FOV: 50 degrees. Kowa VX-10α. Color fundus photograph
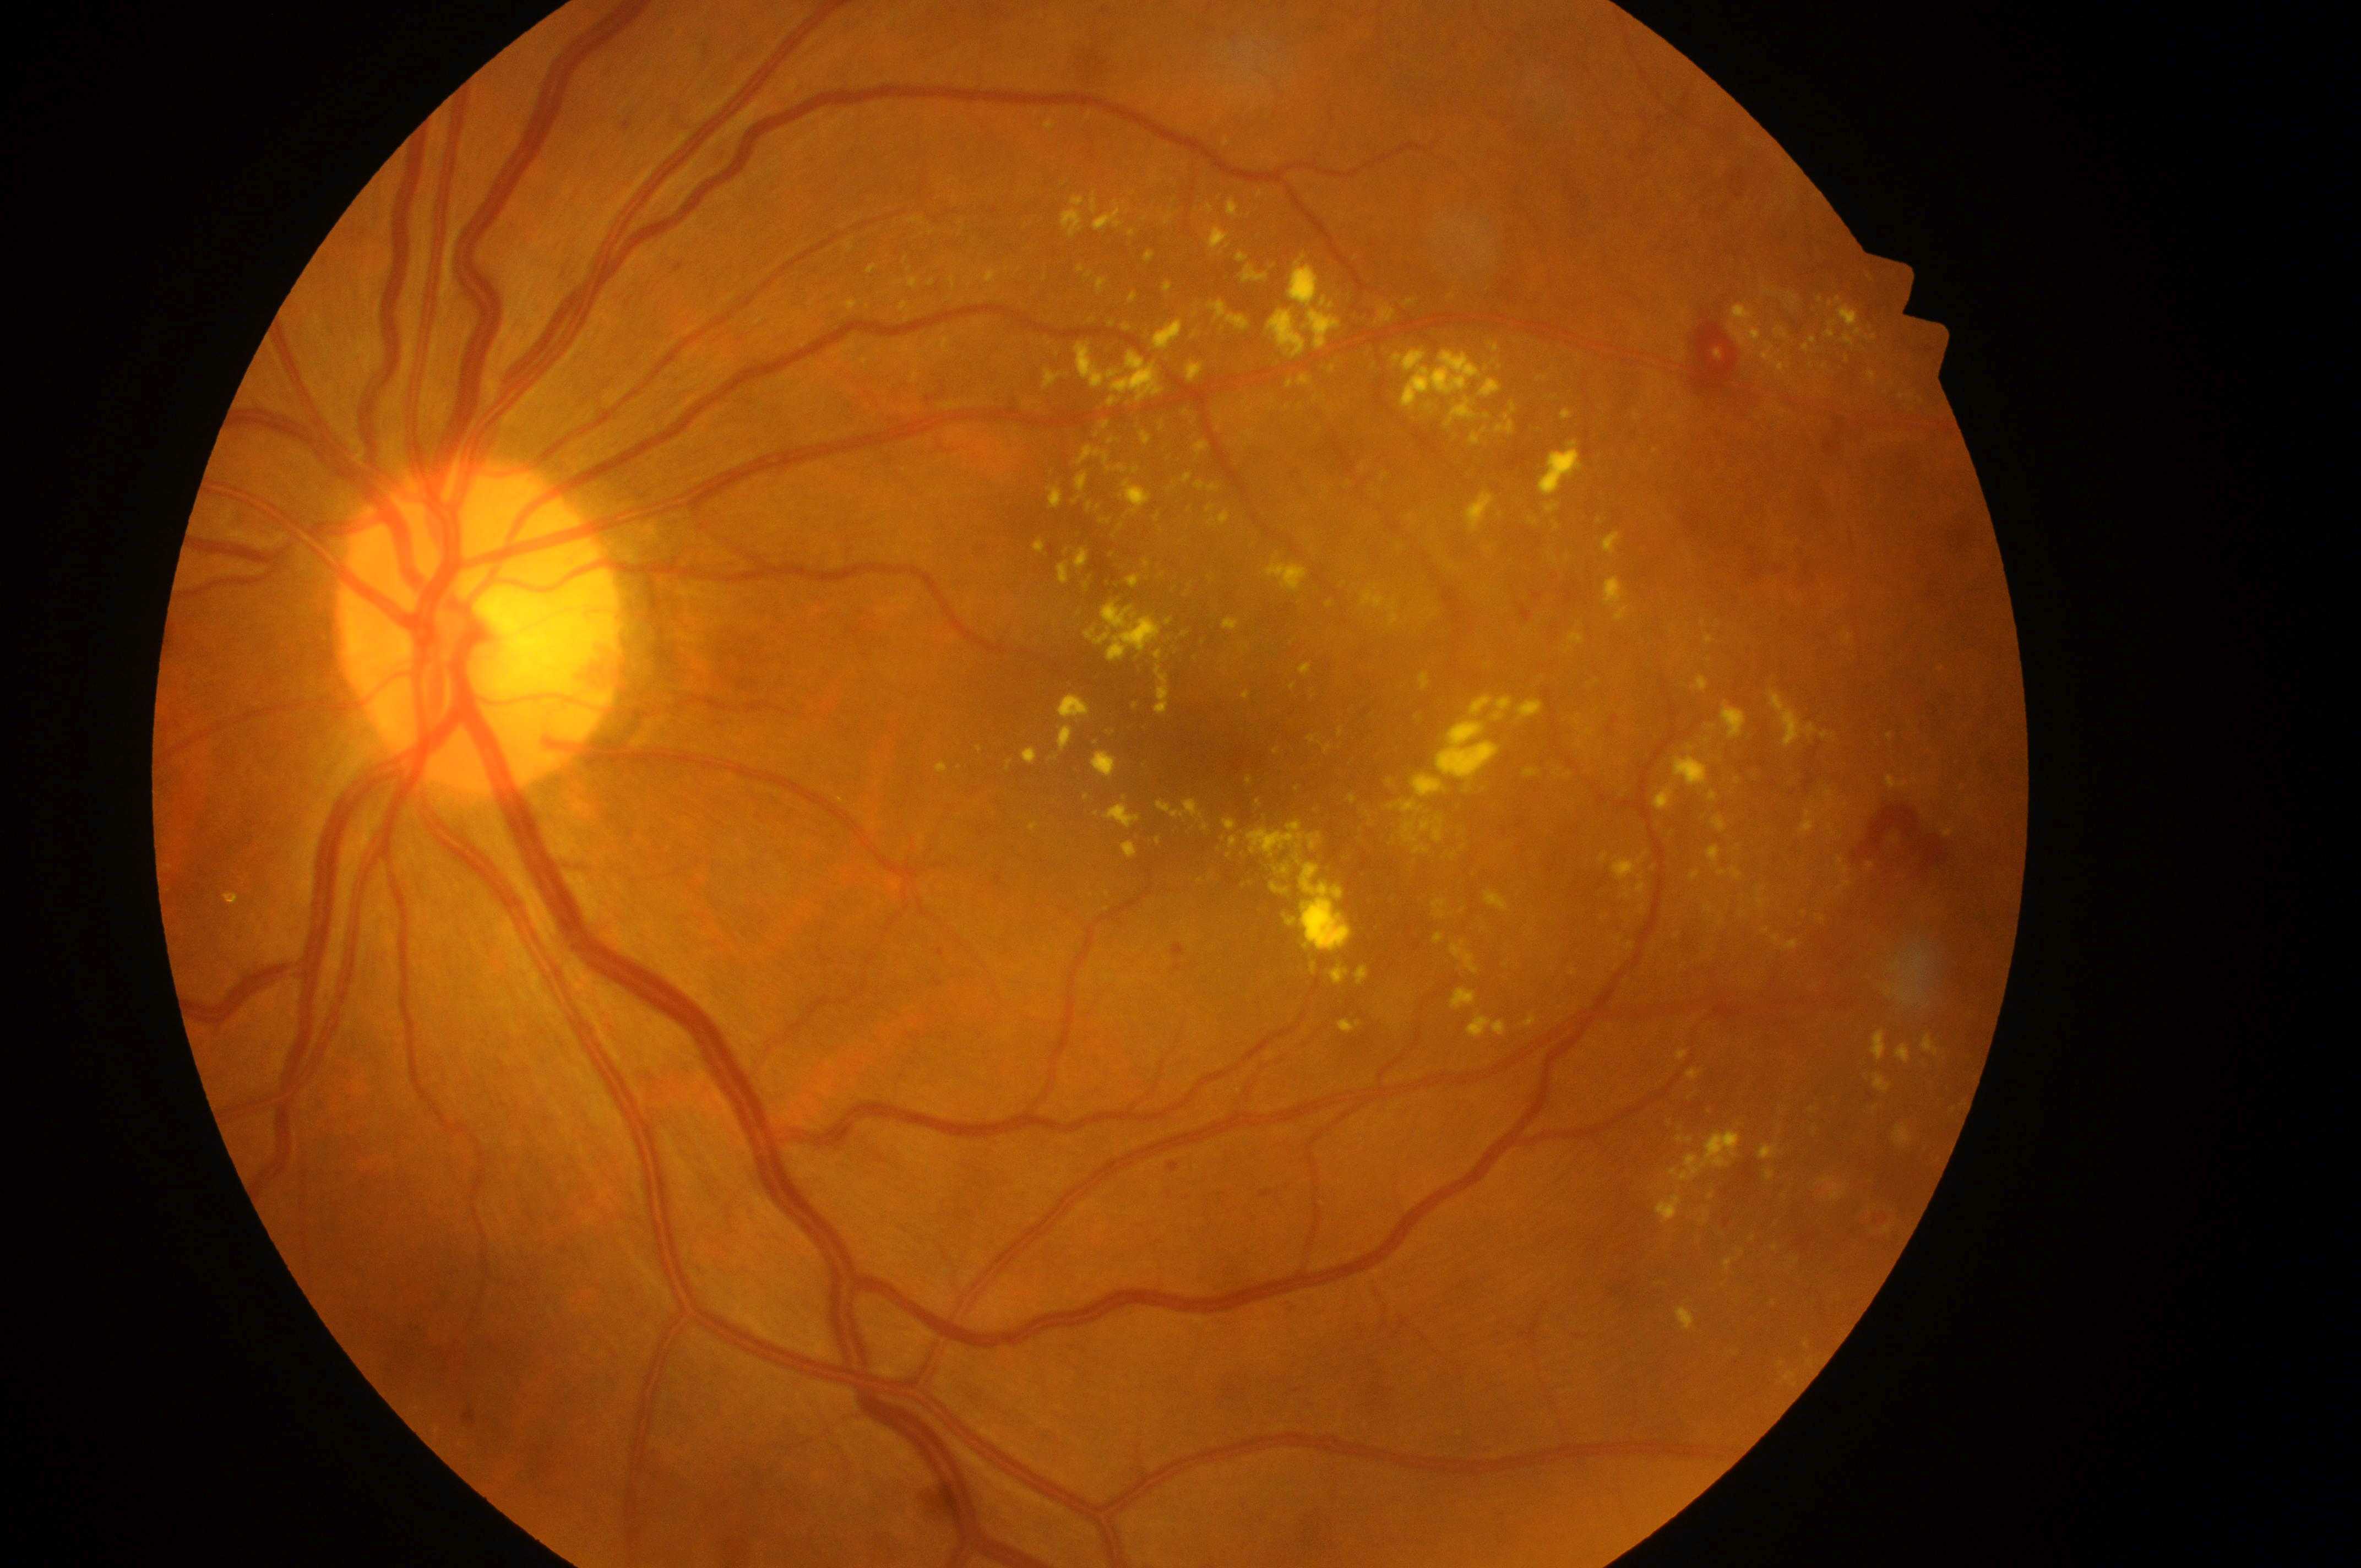
Q: What is the DR grade?
A: 4/4
Q: What disease class is present?
A: proliferative diabetic retinopathy
Q: What is the laterality?
A: oculus sinister
Q: Macular edema risk?
A: 2
Q: Fovea center?
A: 1186px, 748px
Q: Where is the optic disc?
A: 466px, 643px